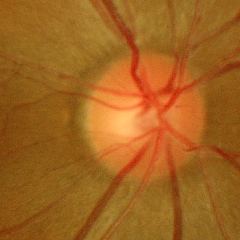
No glaucomatous optic neuropathy.